Ultra-widefield fundus mosaic
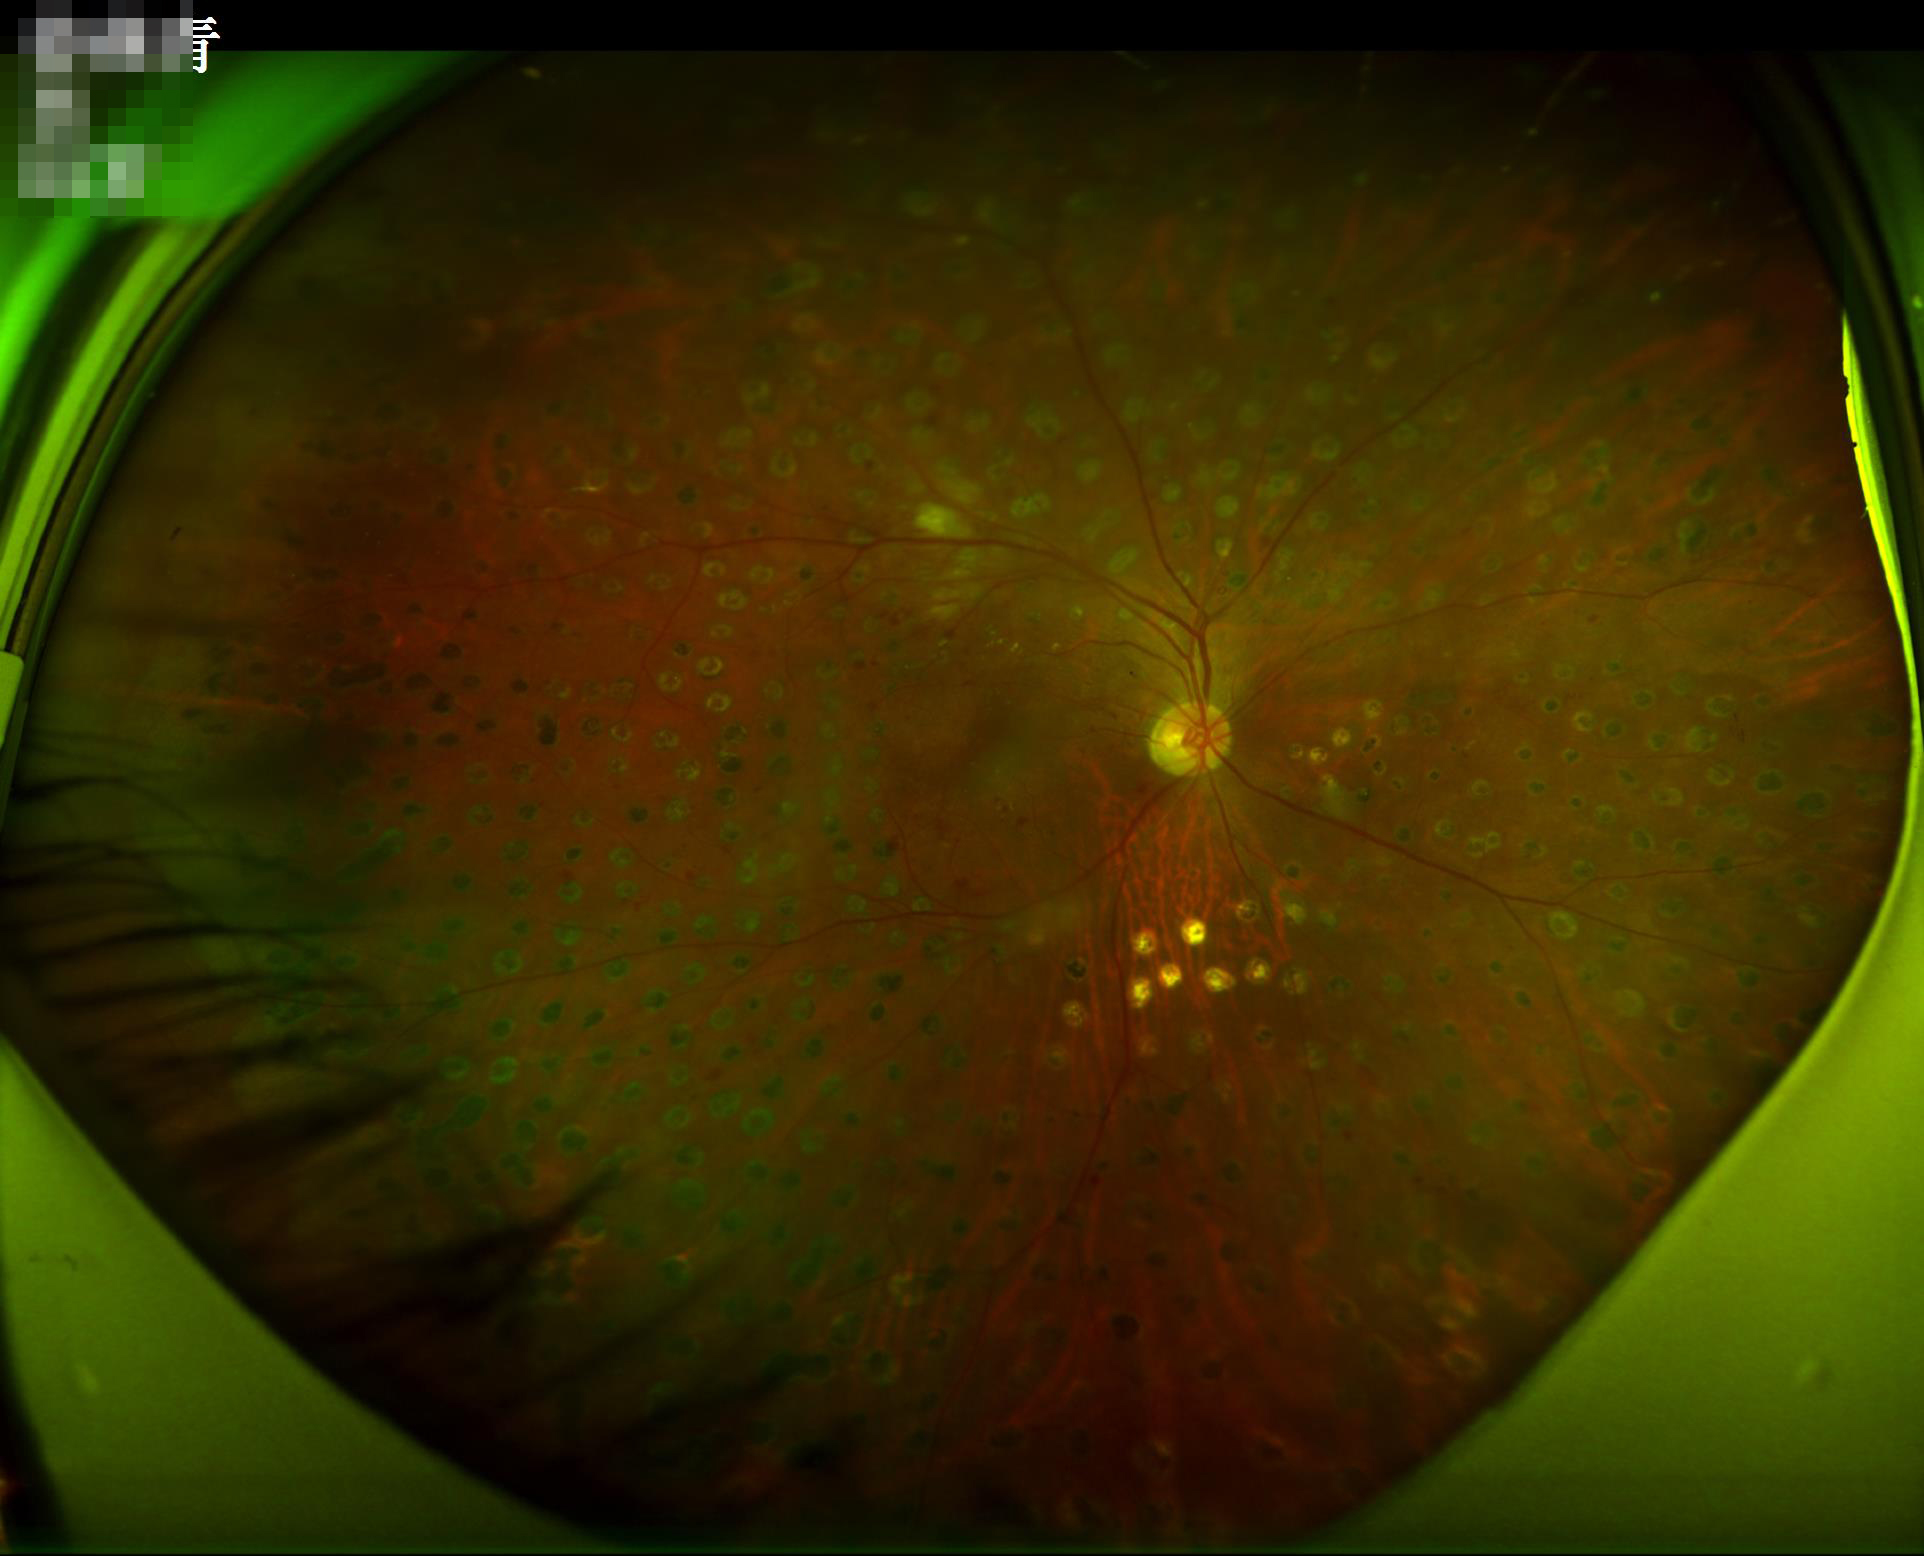
Quality assessment: focus: sharp throughout the field; overall: adequate for clinical interpretation; illumination: no over- or under-exposure.